Captured without pupil dilation, 240x240, disc-centered field — 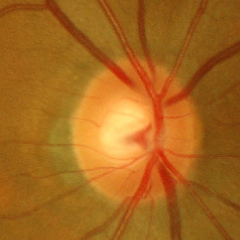
Fundus image with findings of early glaucomatous optic neuropathy.